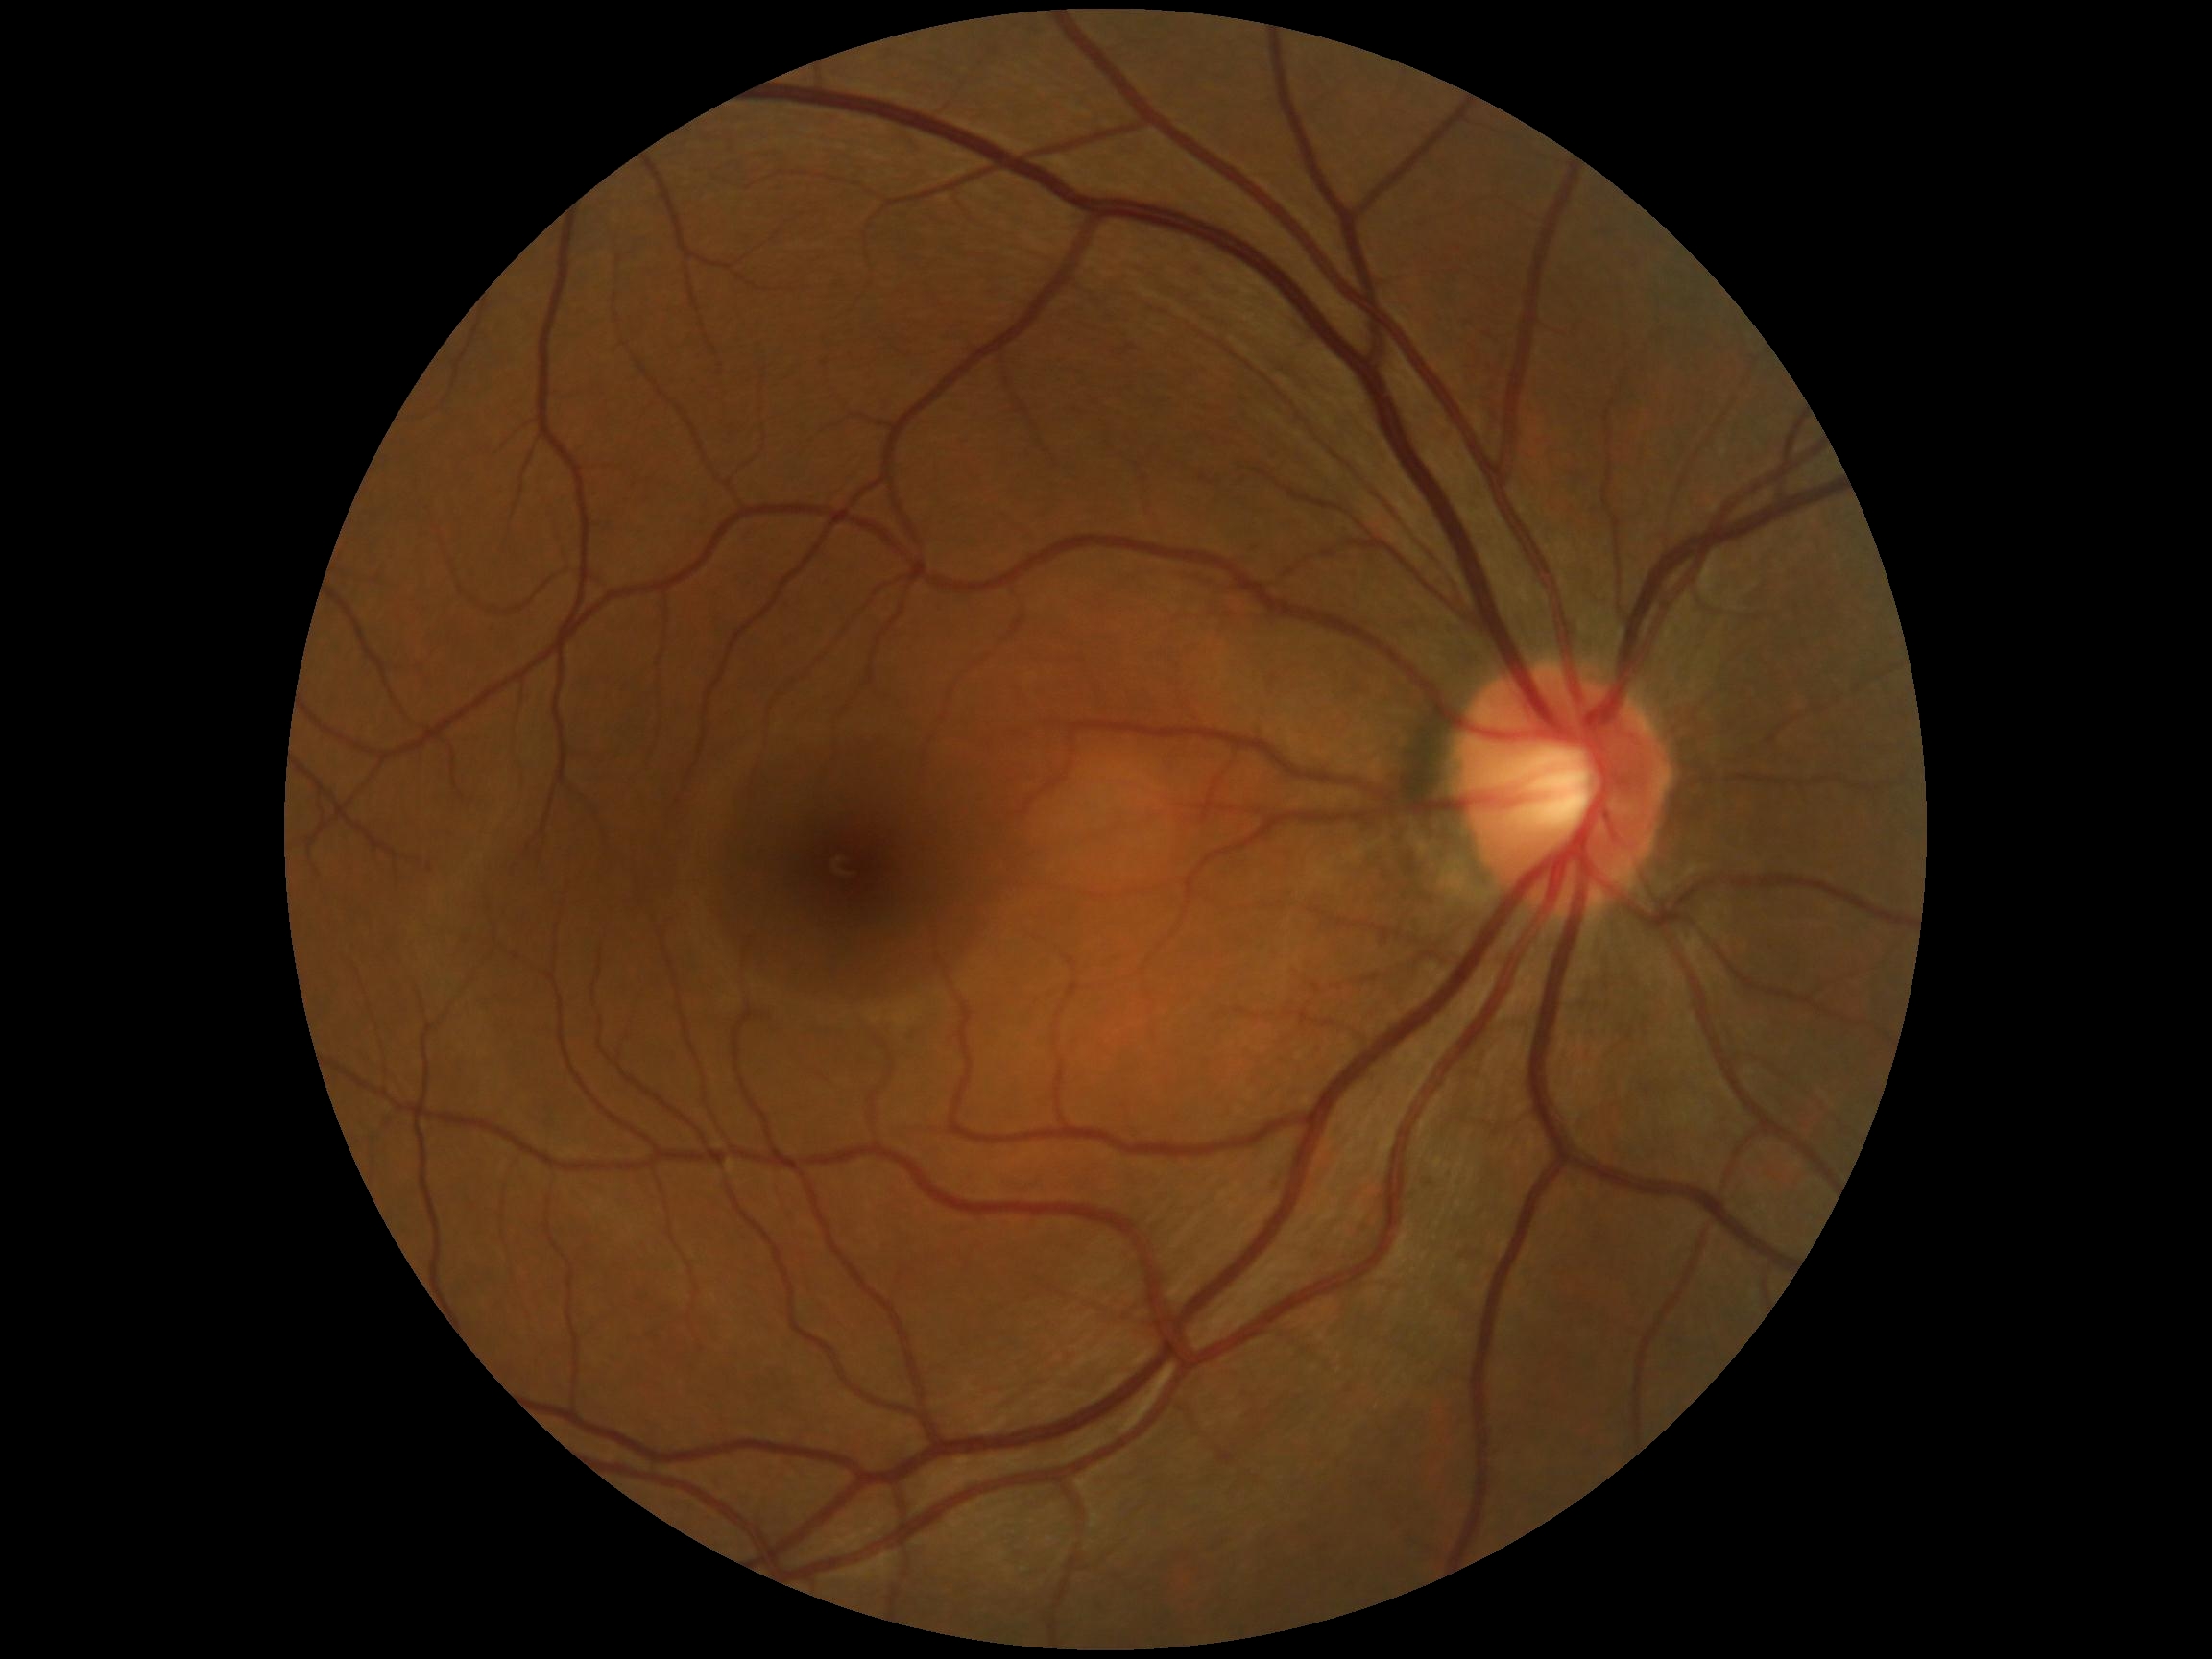
DR stage is no apparent retinopathy (grade 0) — no visible signs of diabetic retinopathy.